Color fundus photograph, 512x512: 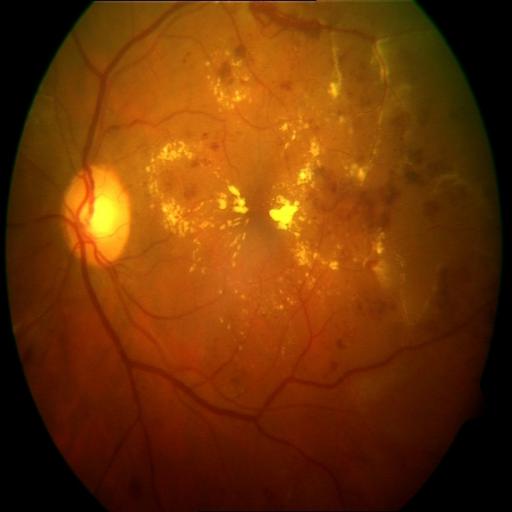
Impression (2): exudation (EDN) | hemorrhagic retinopathy (HR).